50° FOV — 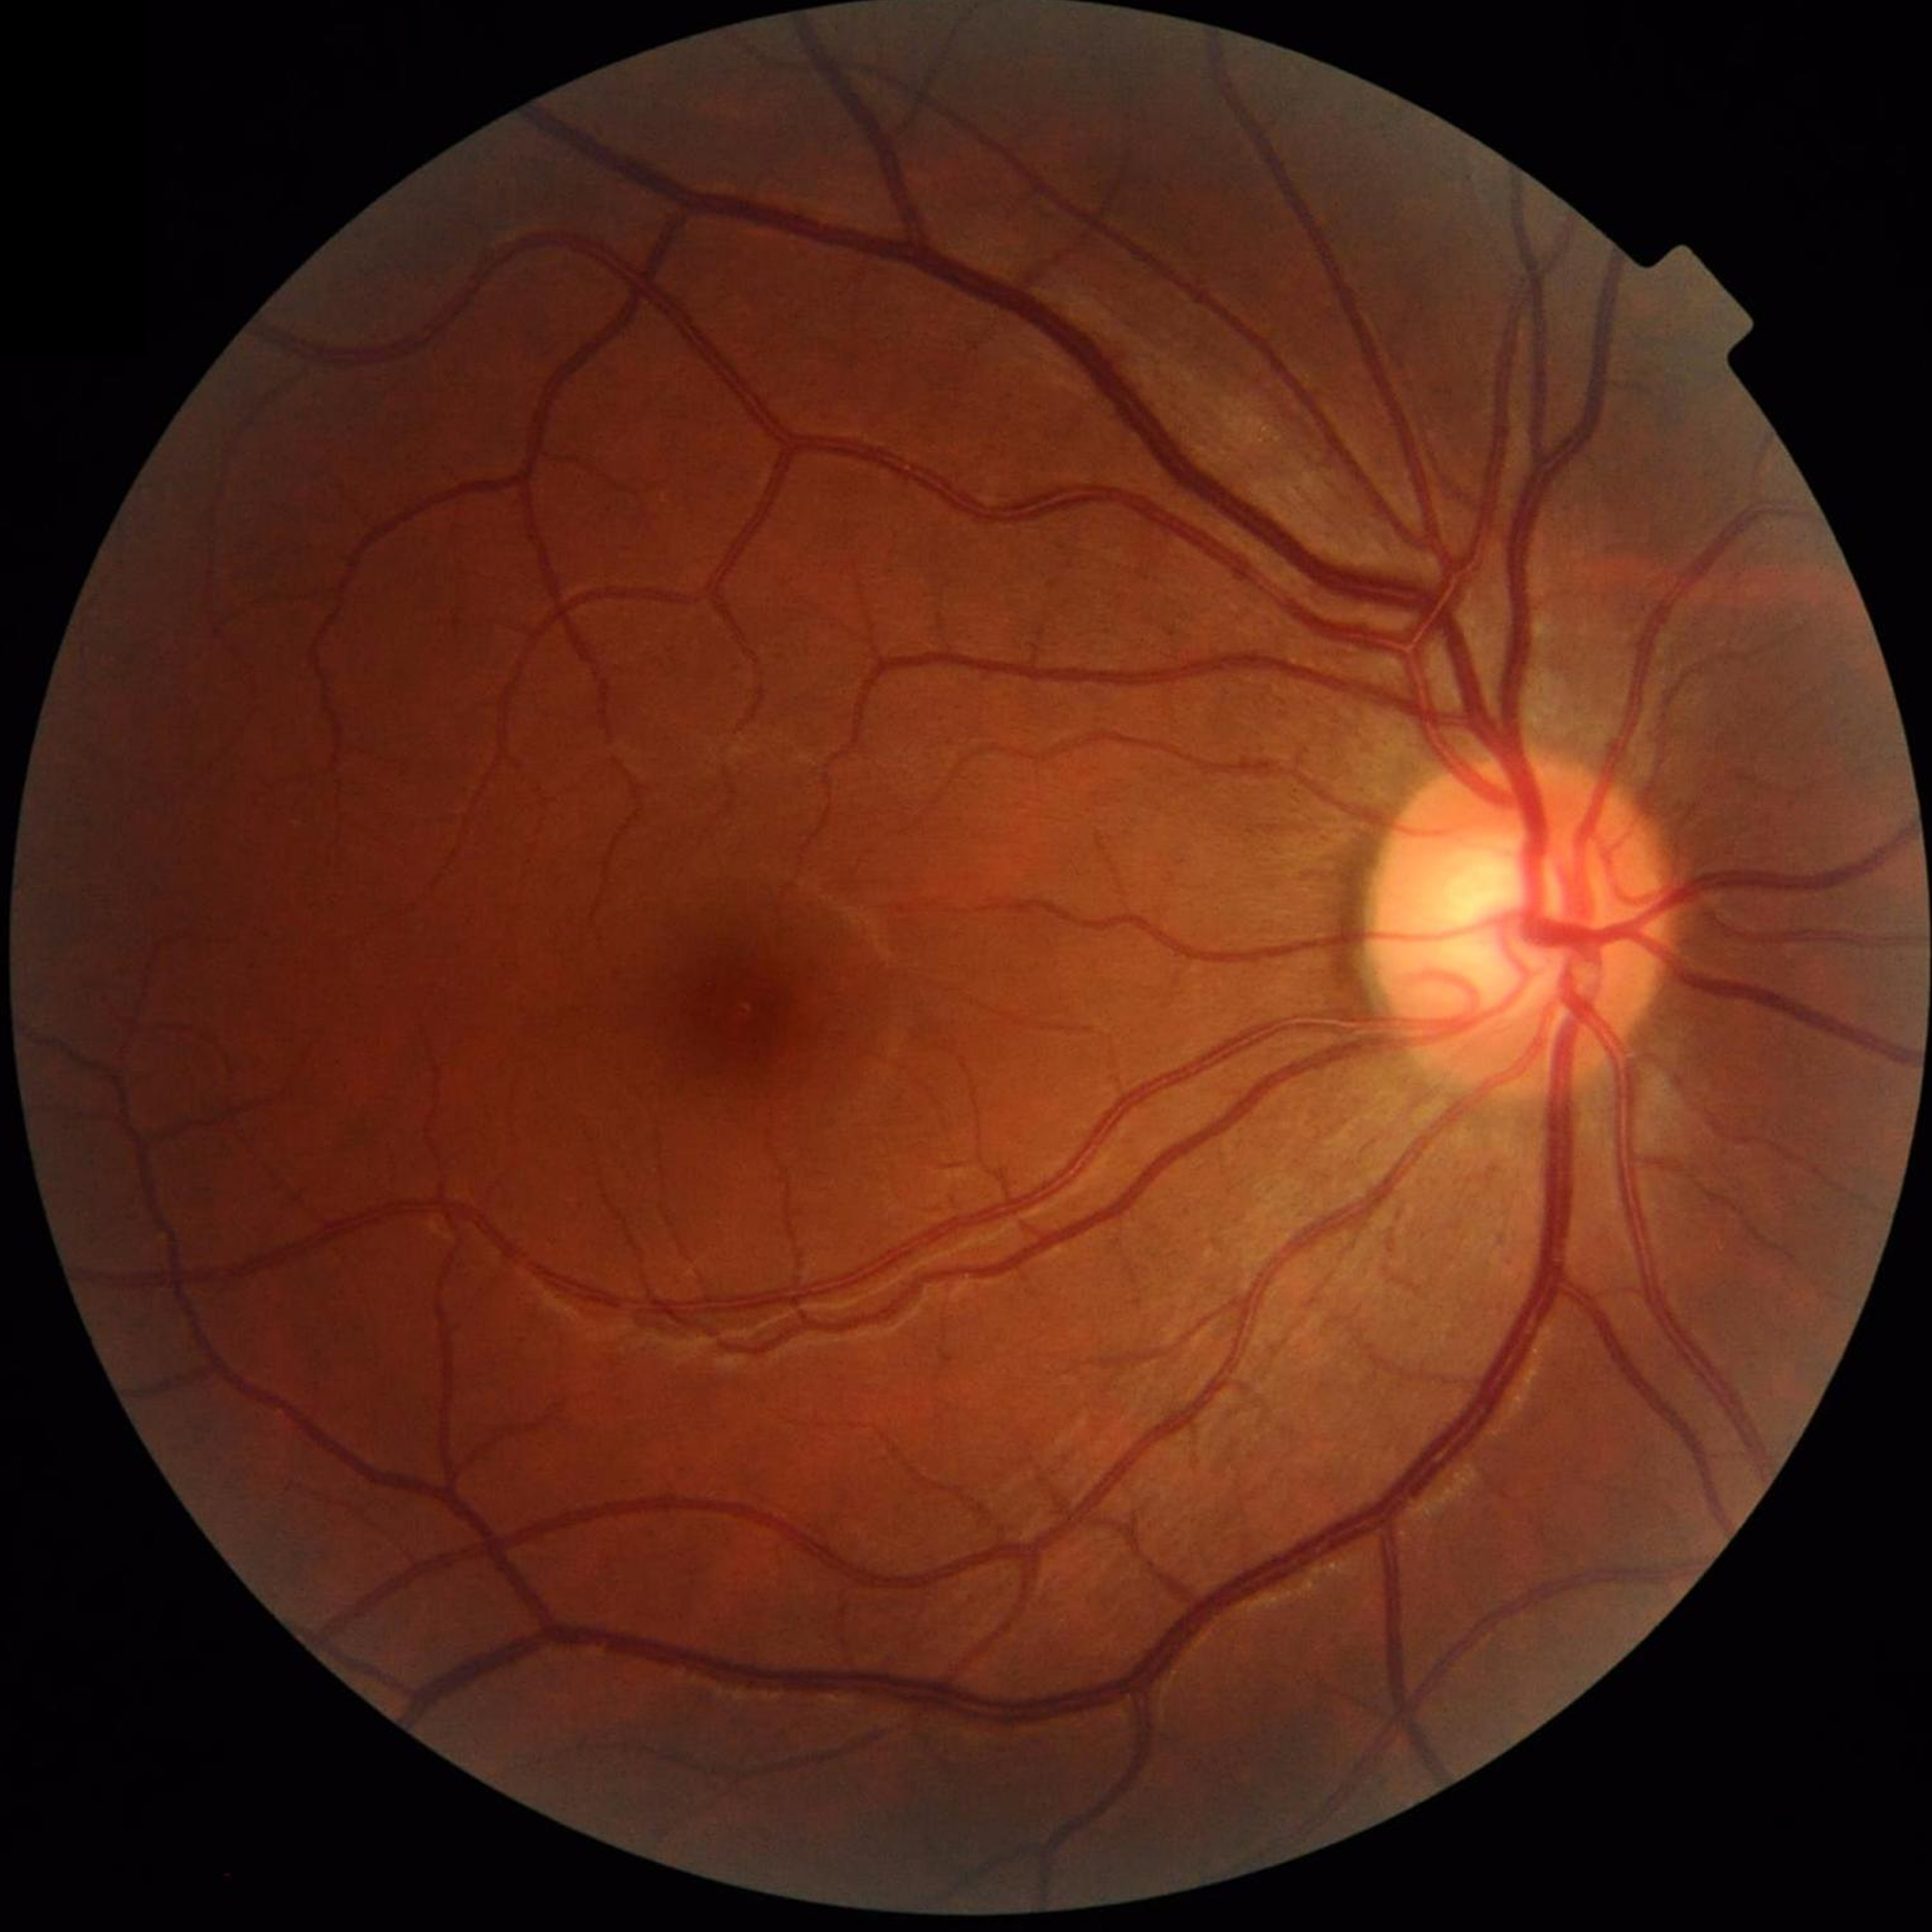 Color fundus photo from a control patient without diagnosed retinal disease.